FOV: 45 degrees. Color fundus image.
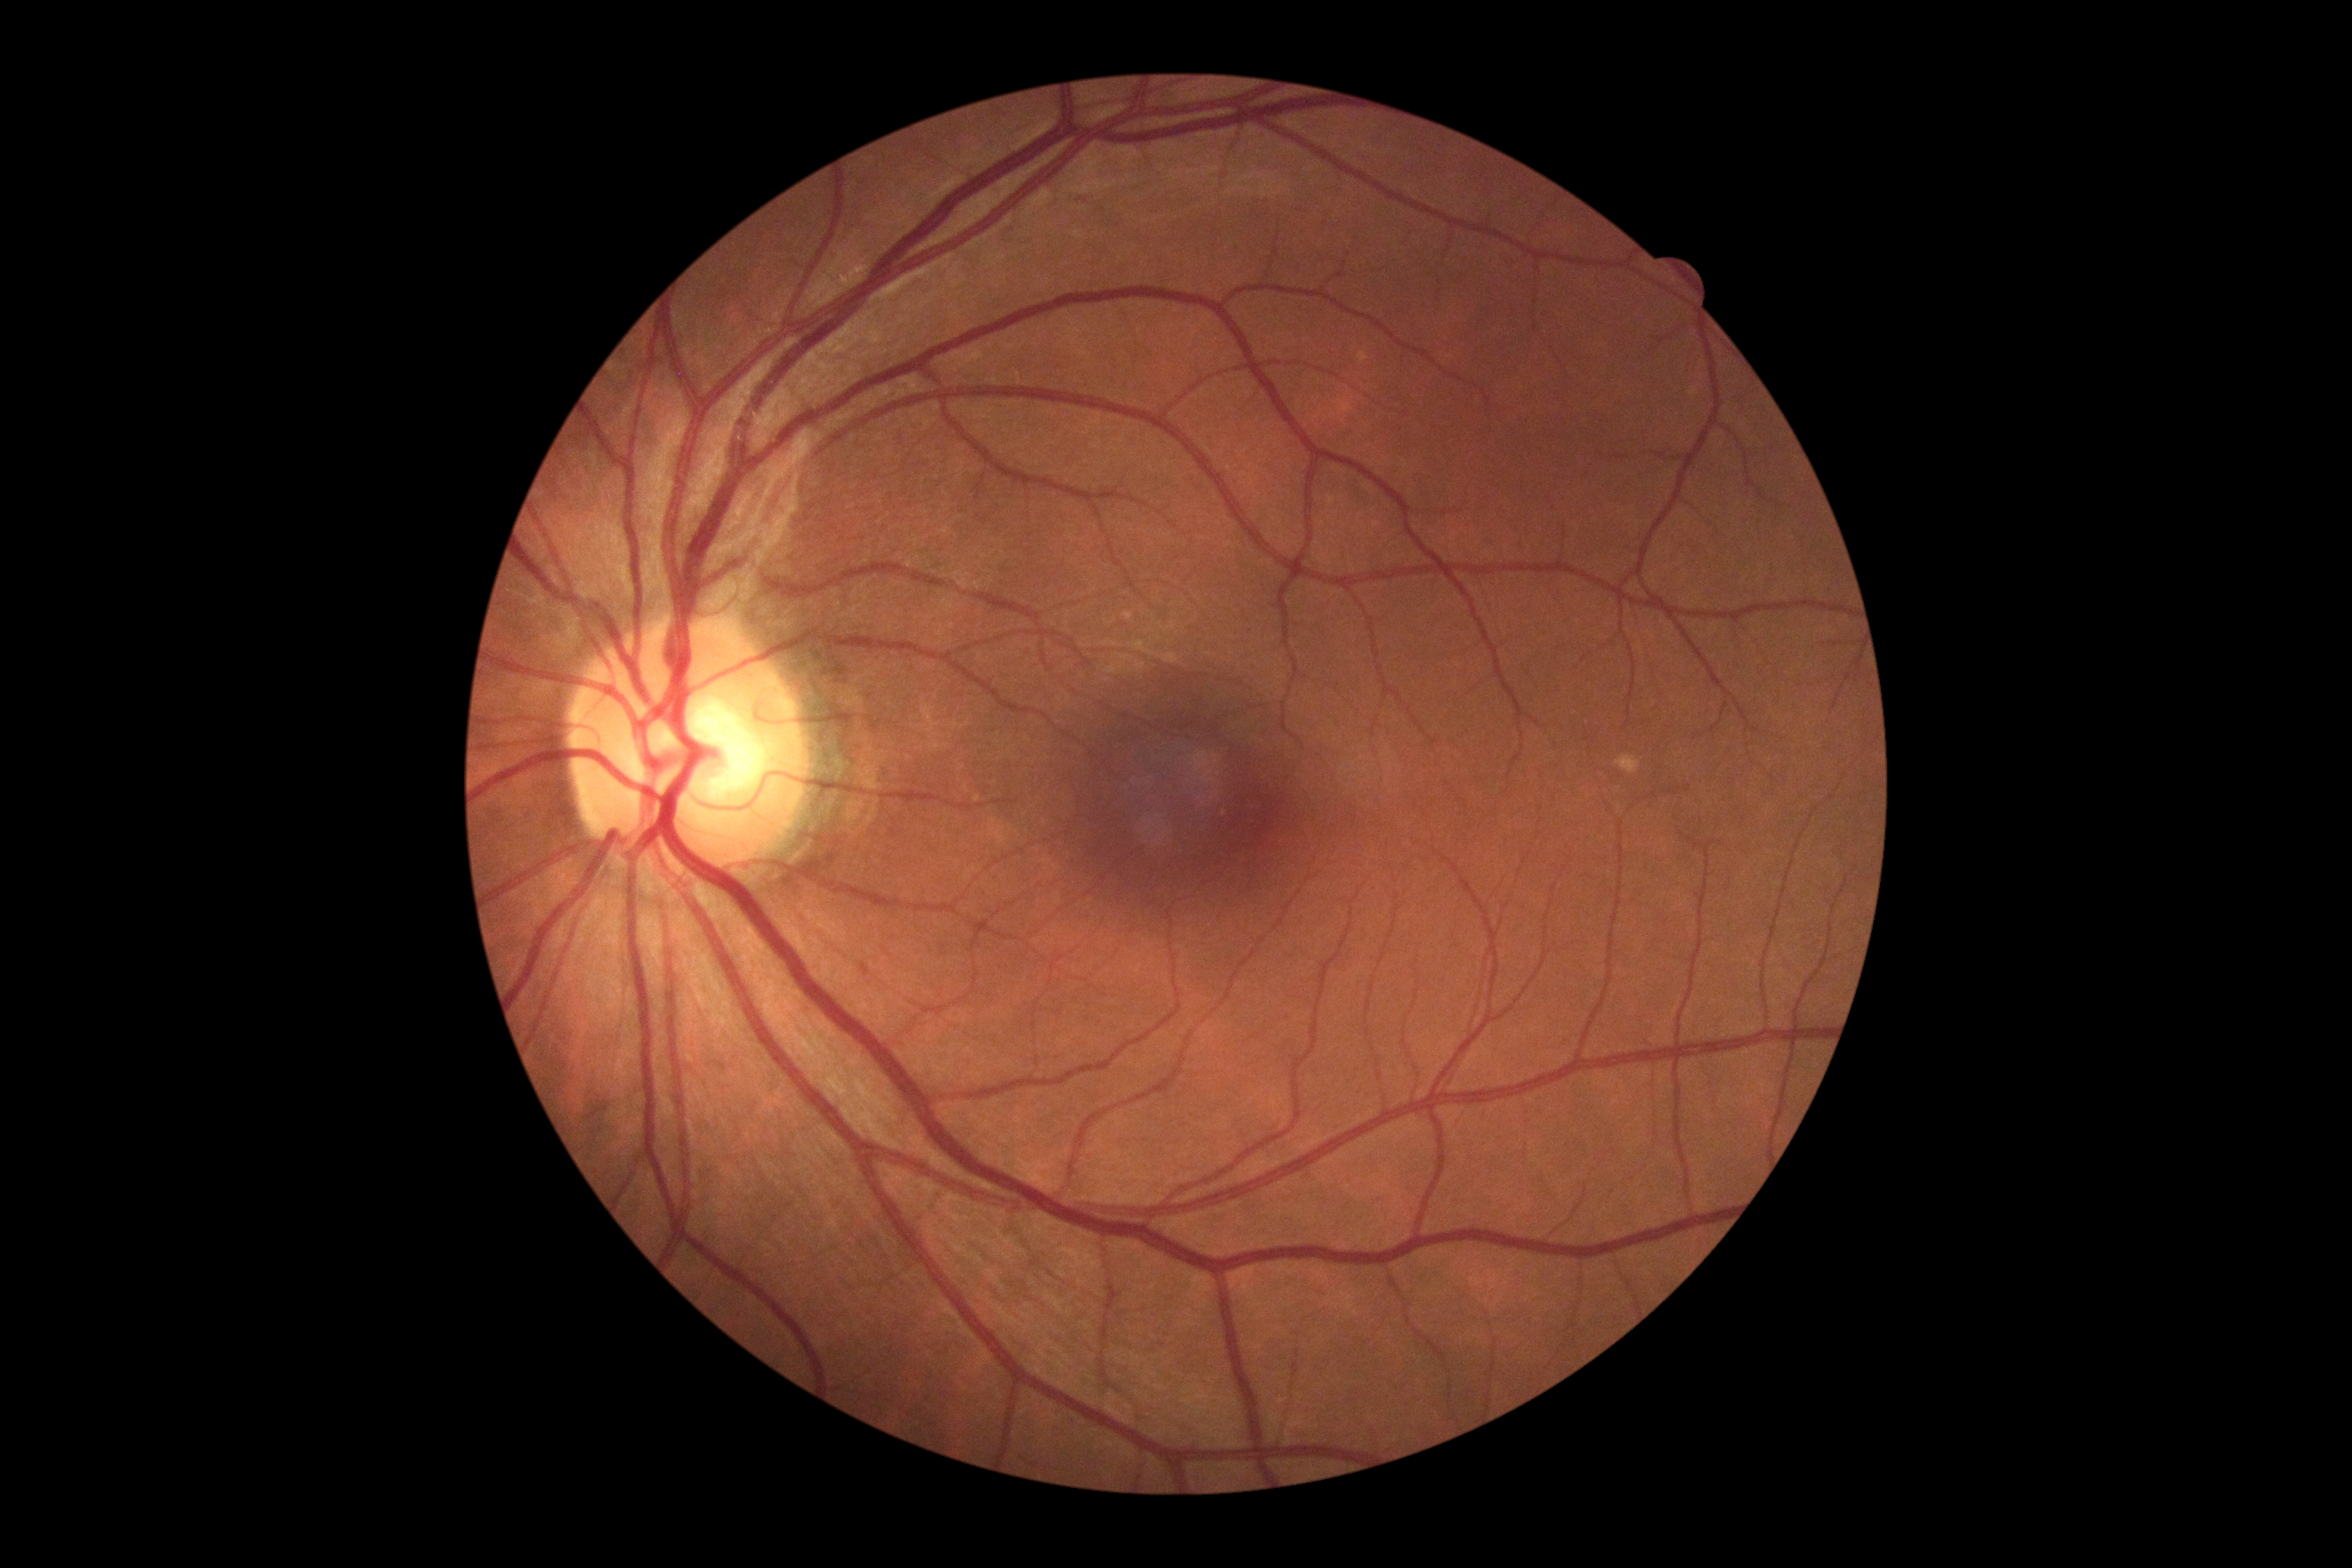
DR stage: no apparent diabetic retinopathy (grade 0).